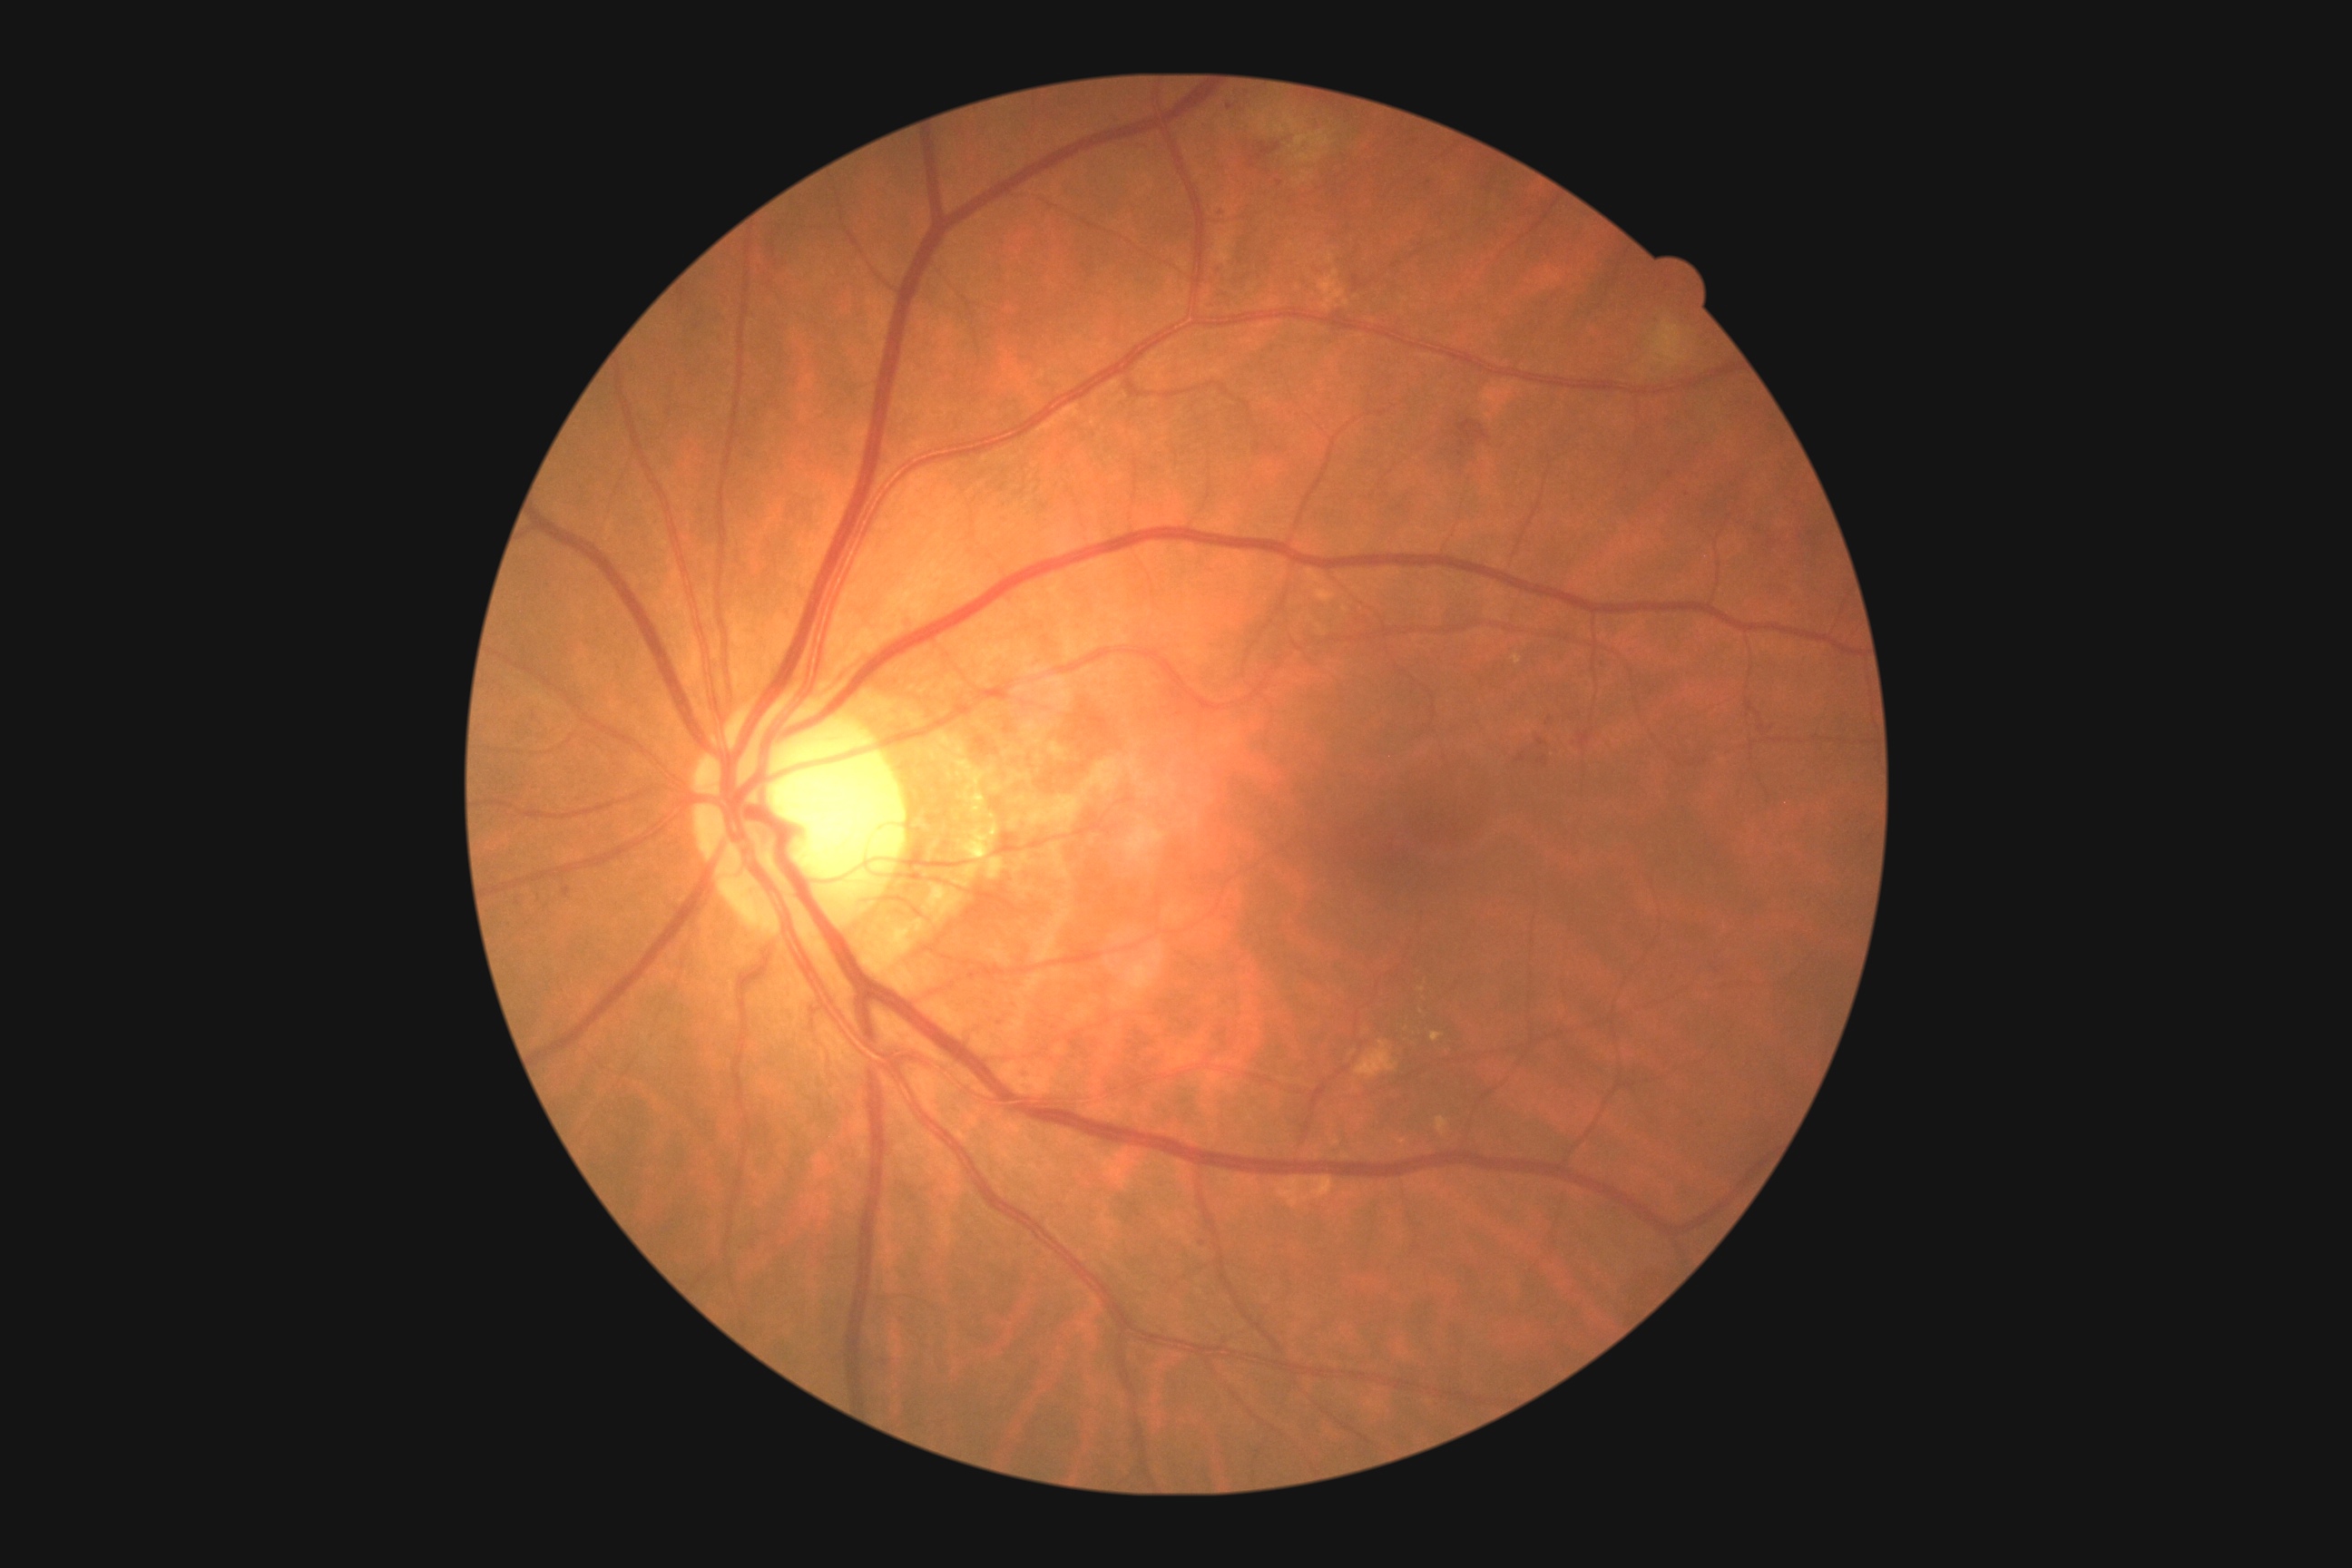

DR grade: 2 (moderate NPDR)